Posterior pole color fundus photograph; Davis DR grading: 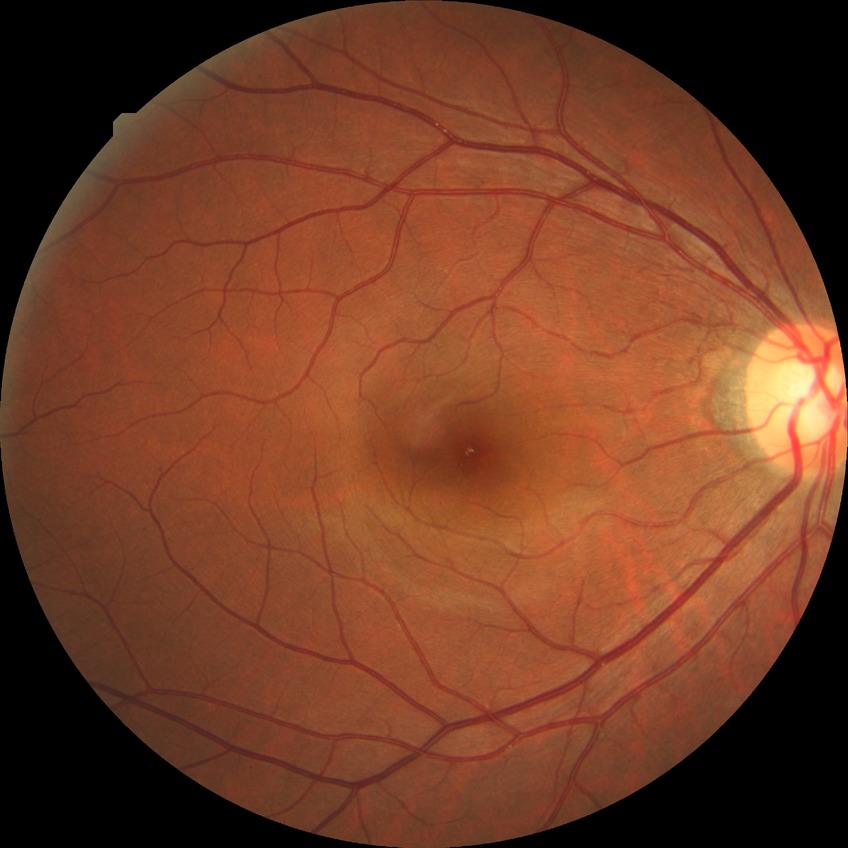 Diabetic retinopathy (DR) is NDR (no diabetic retinopathy).